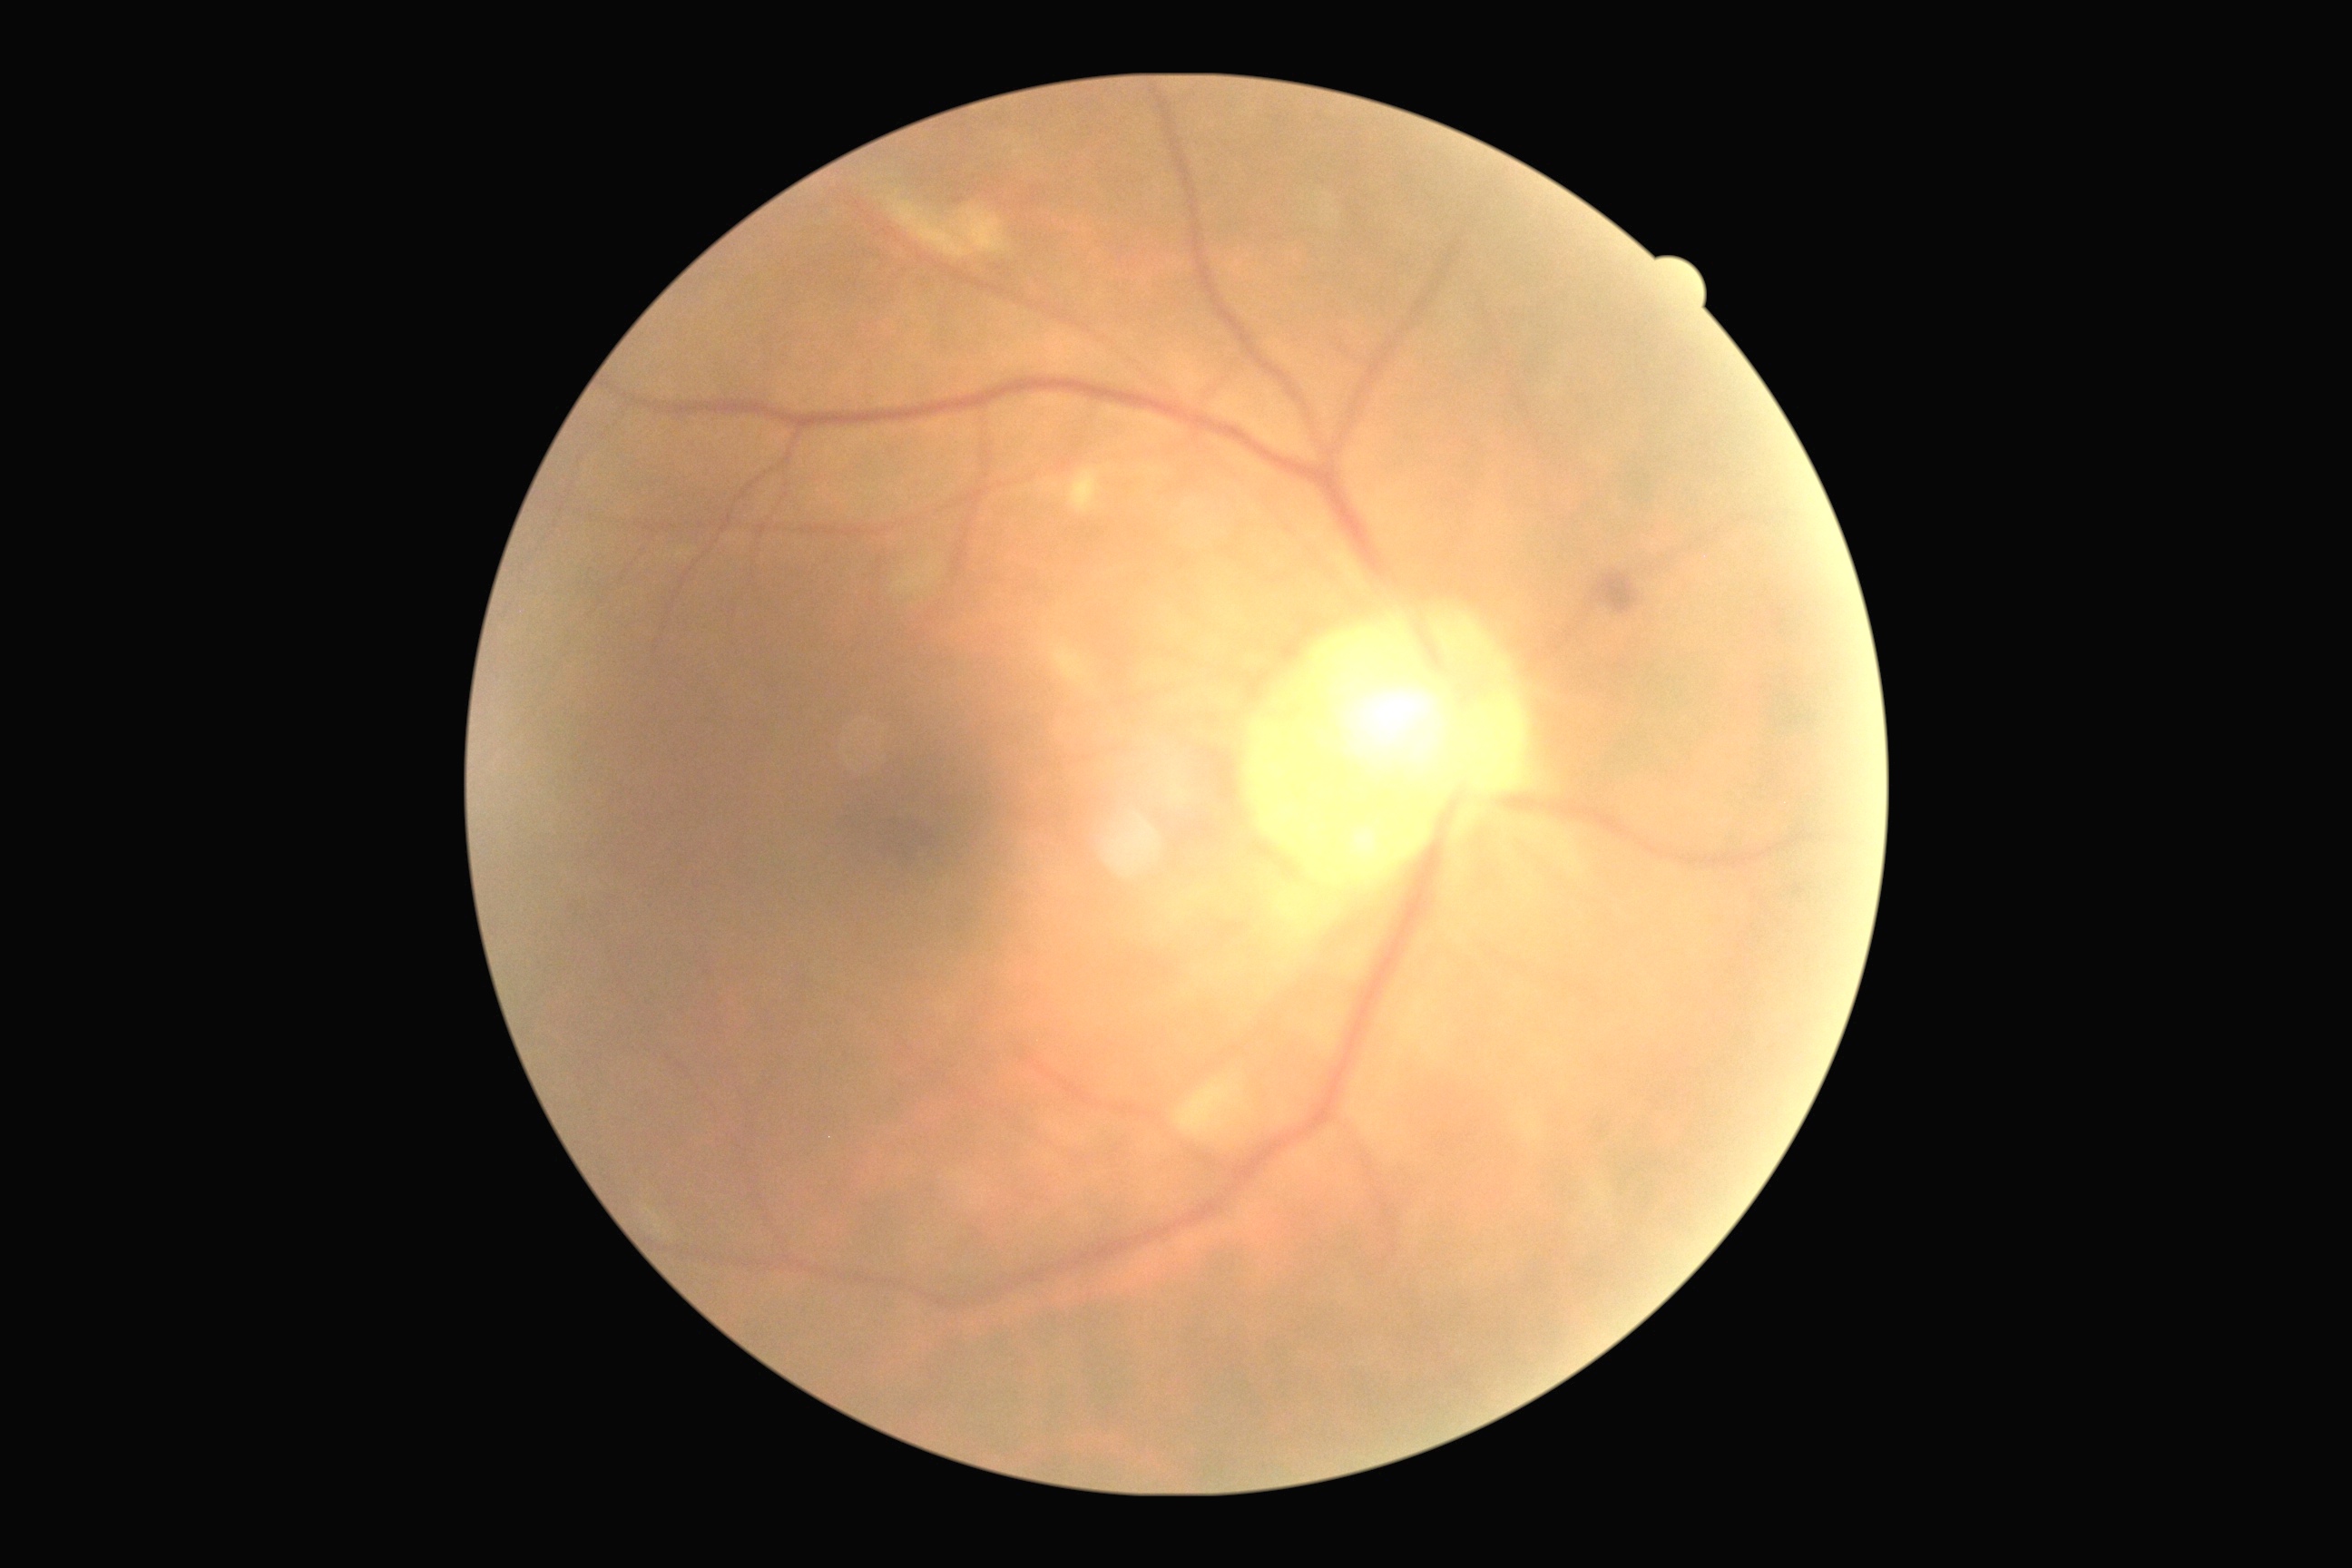
Retinopathy is 2.